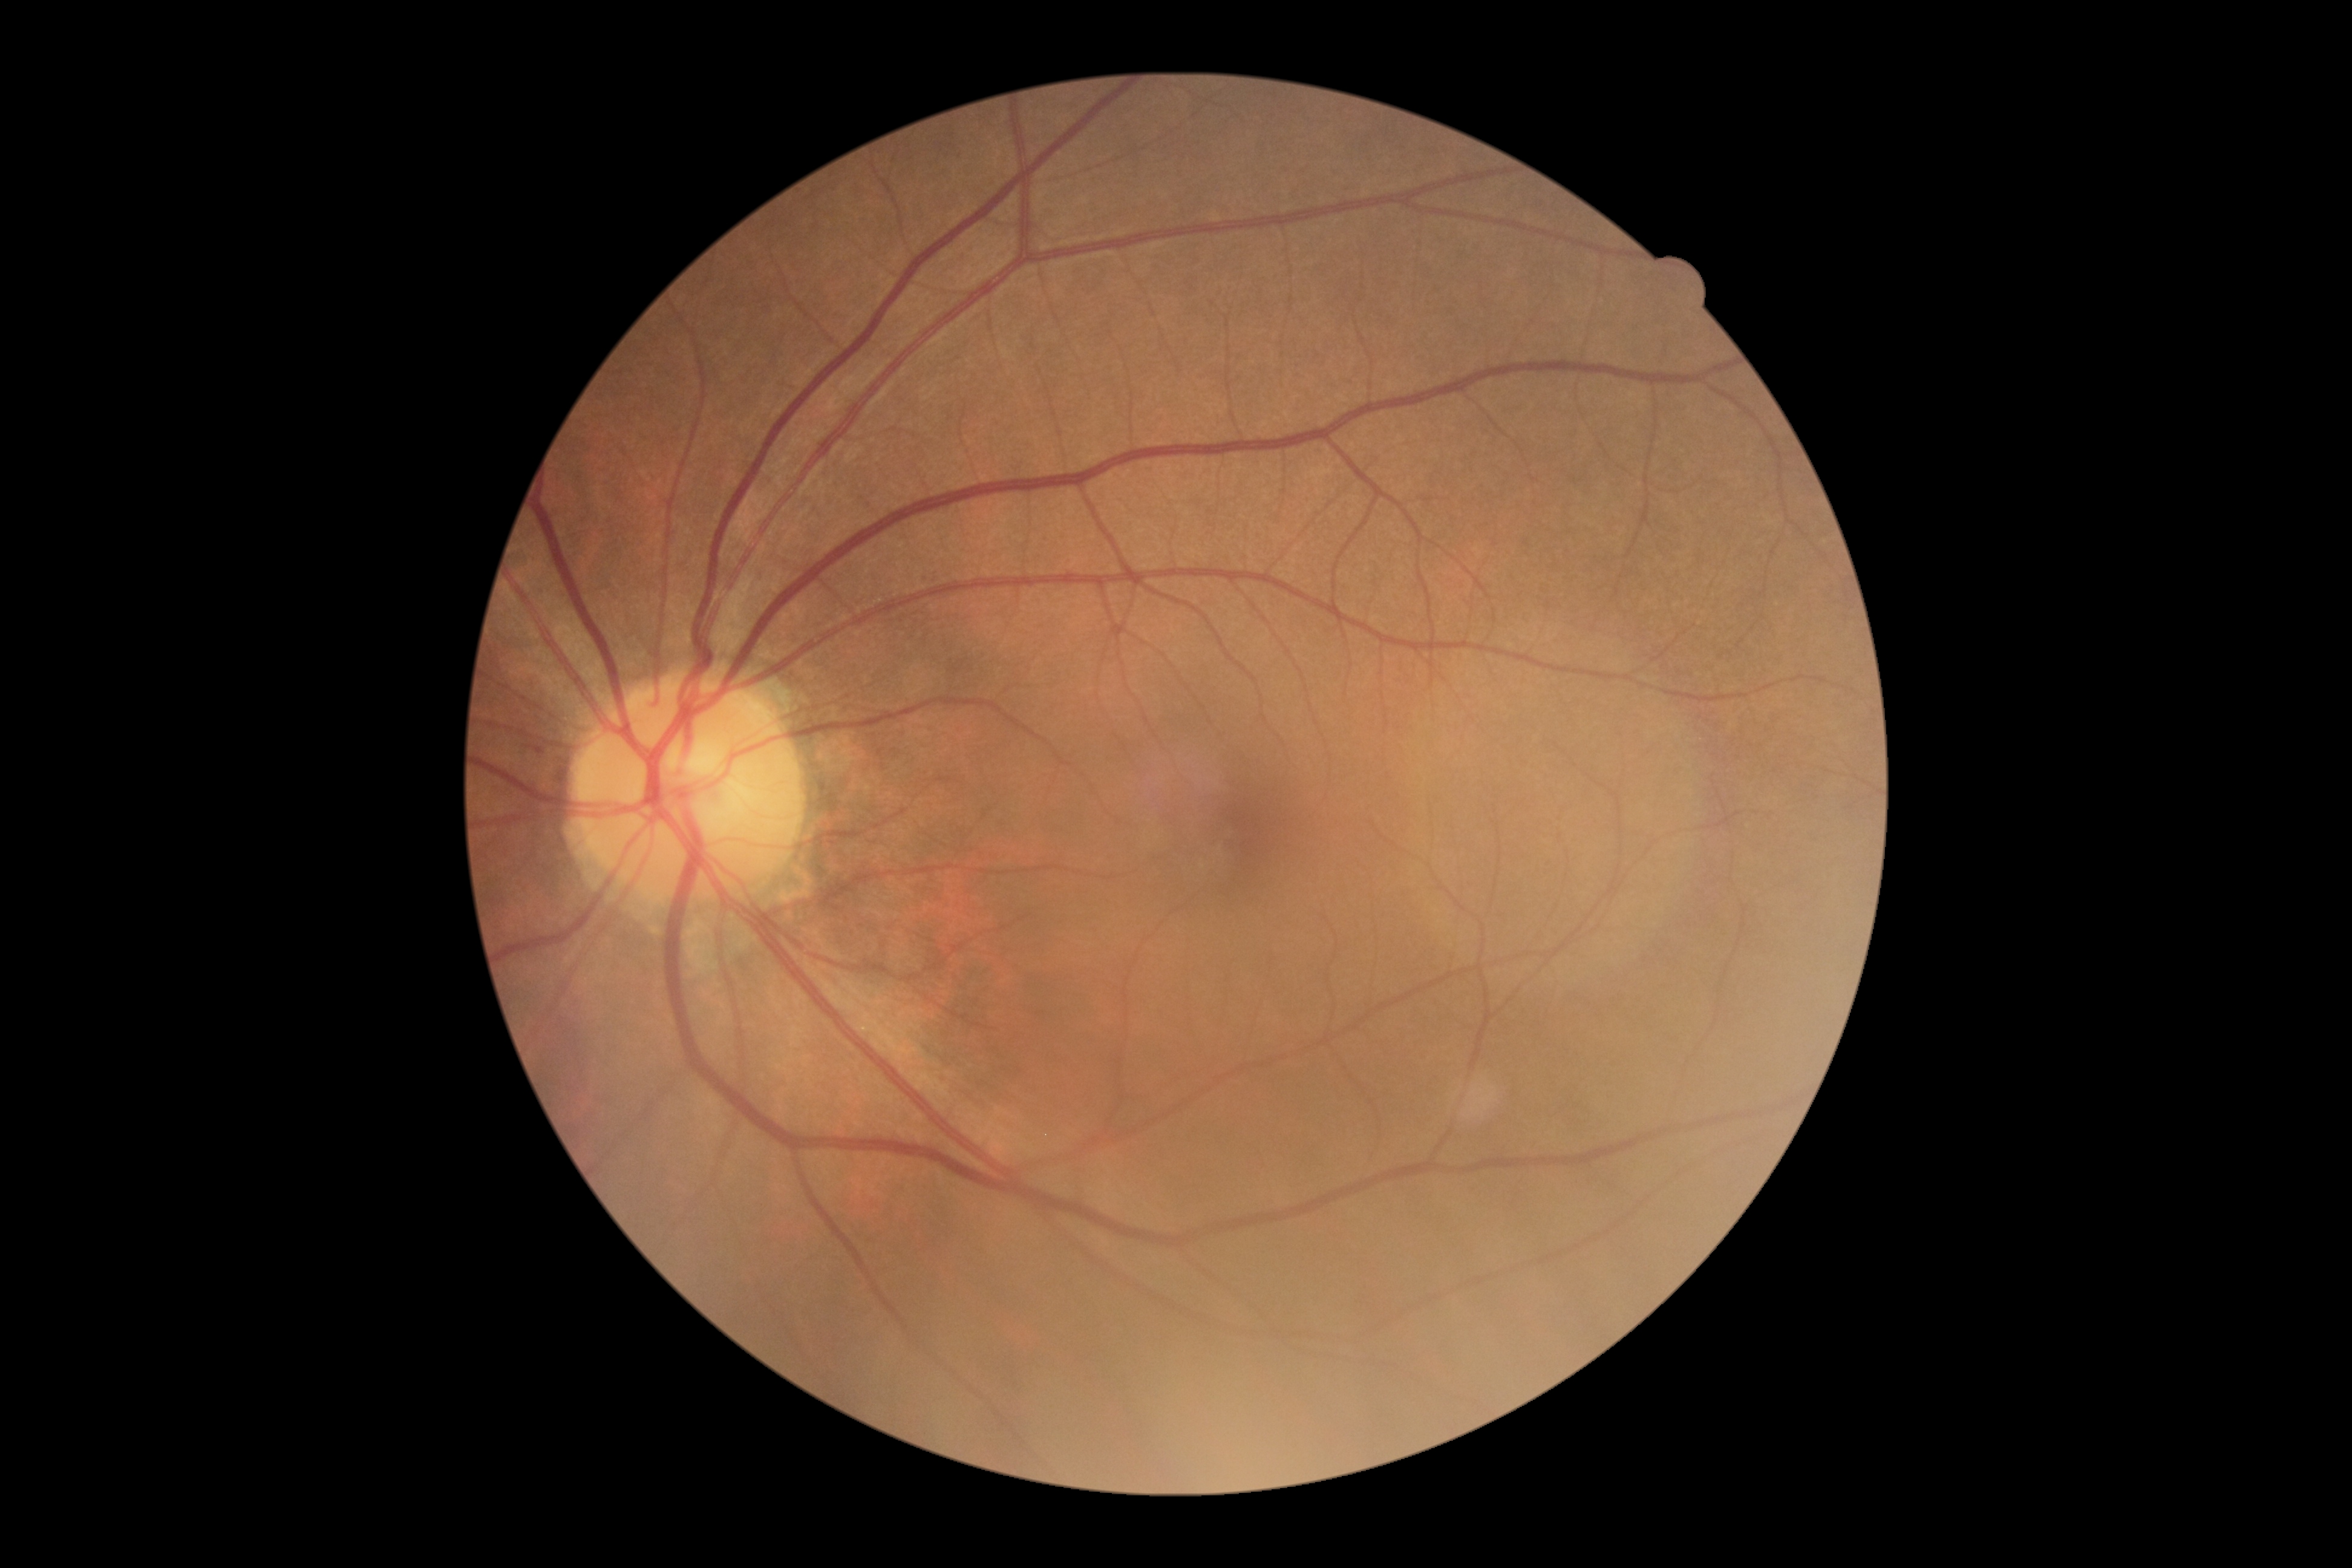
dr_grade: 0 (no apparent retinopathy)